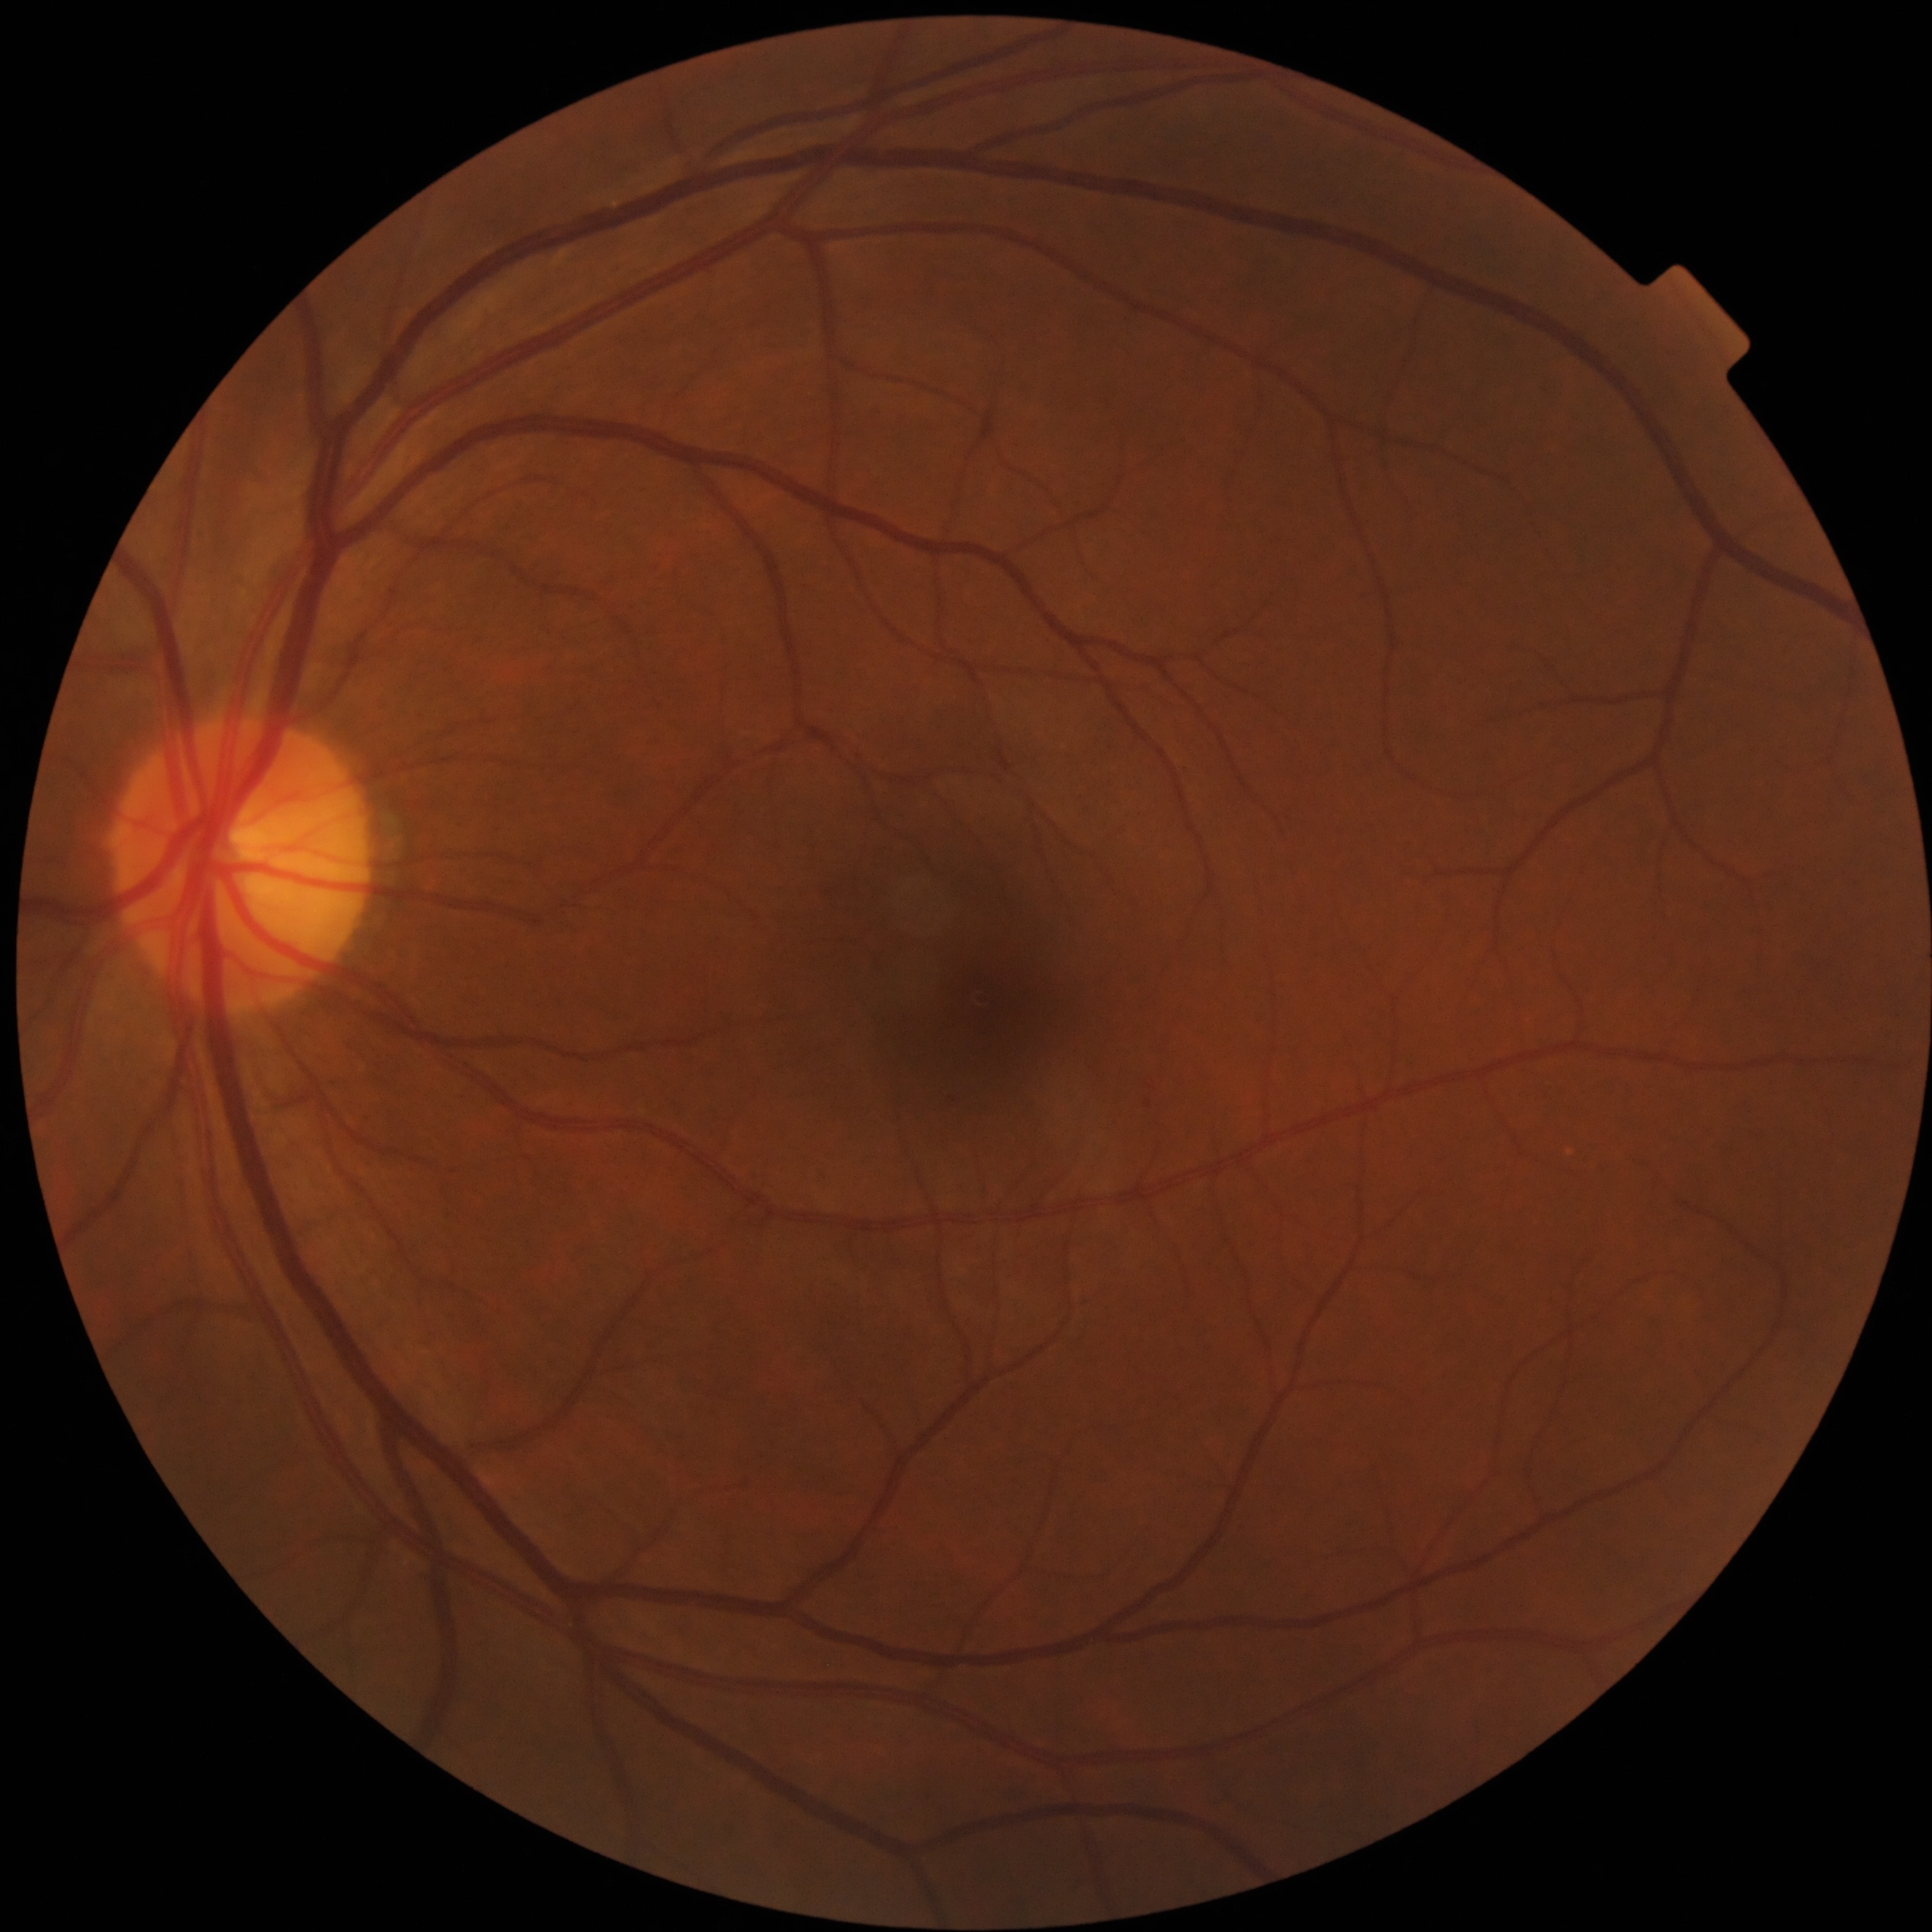 No apparent diabetic retinopathy. DR: grade 0 (no apparent retinopathy) — no visible signs of diabetic retinopathy.